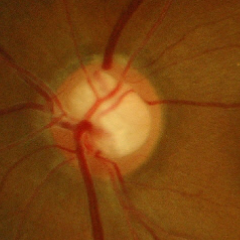
Color fundus photograph showing early glaucomatous optic neuropathy.